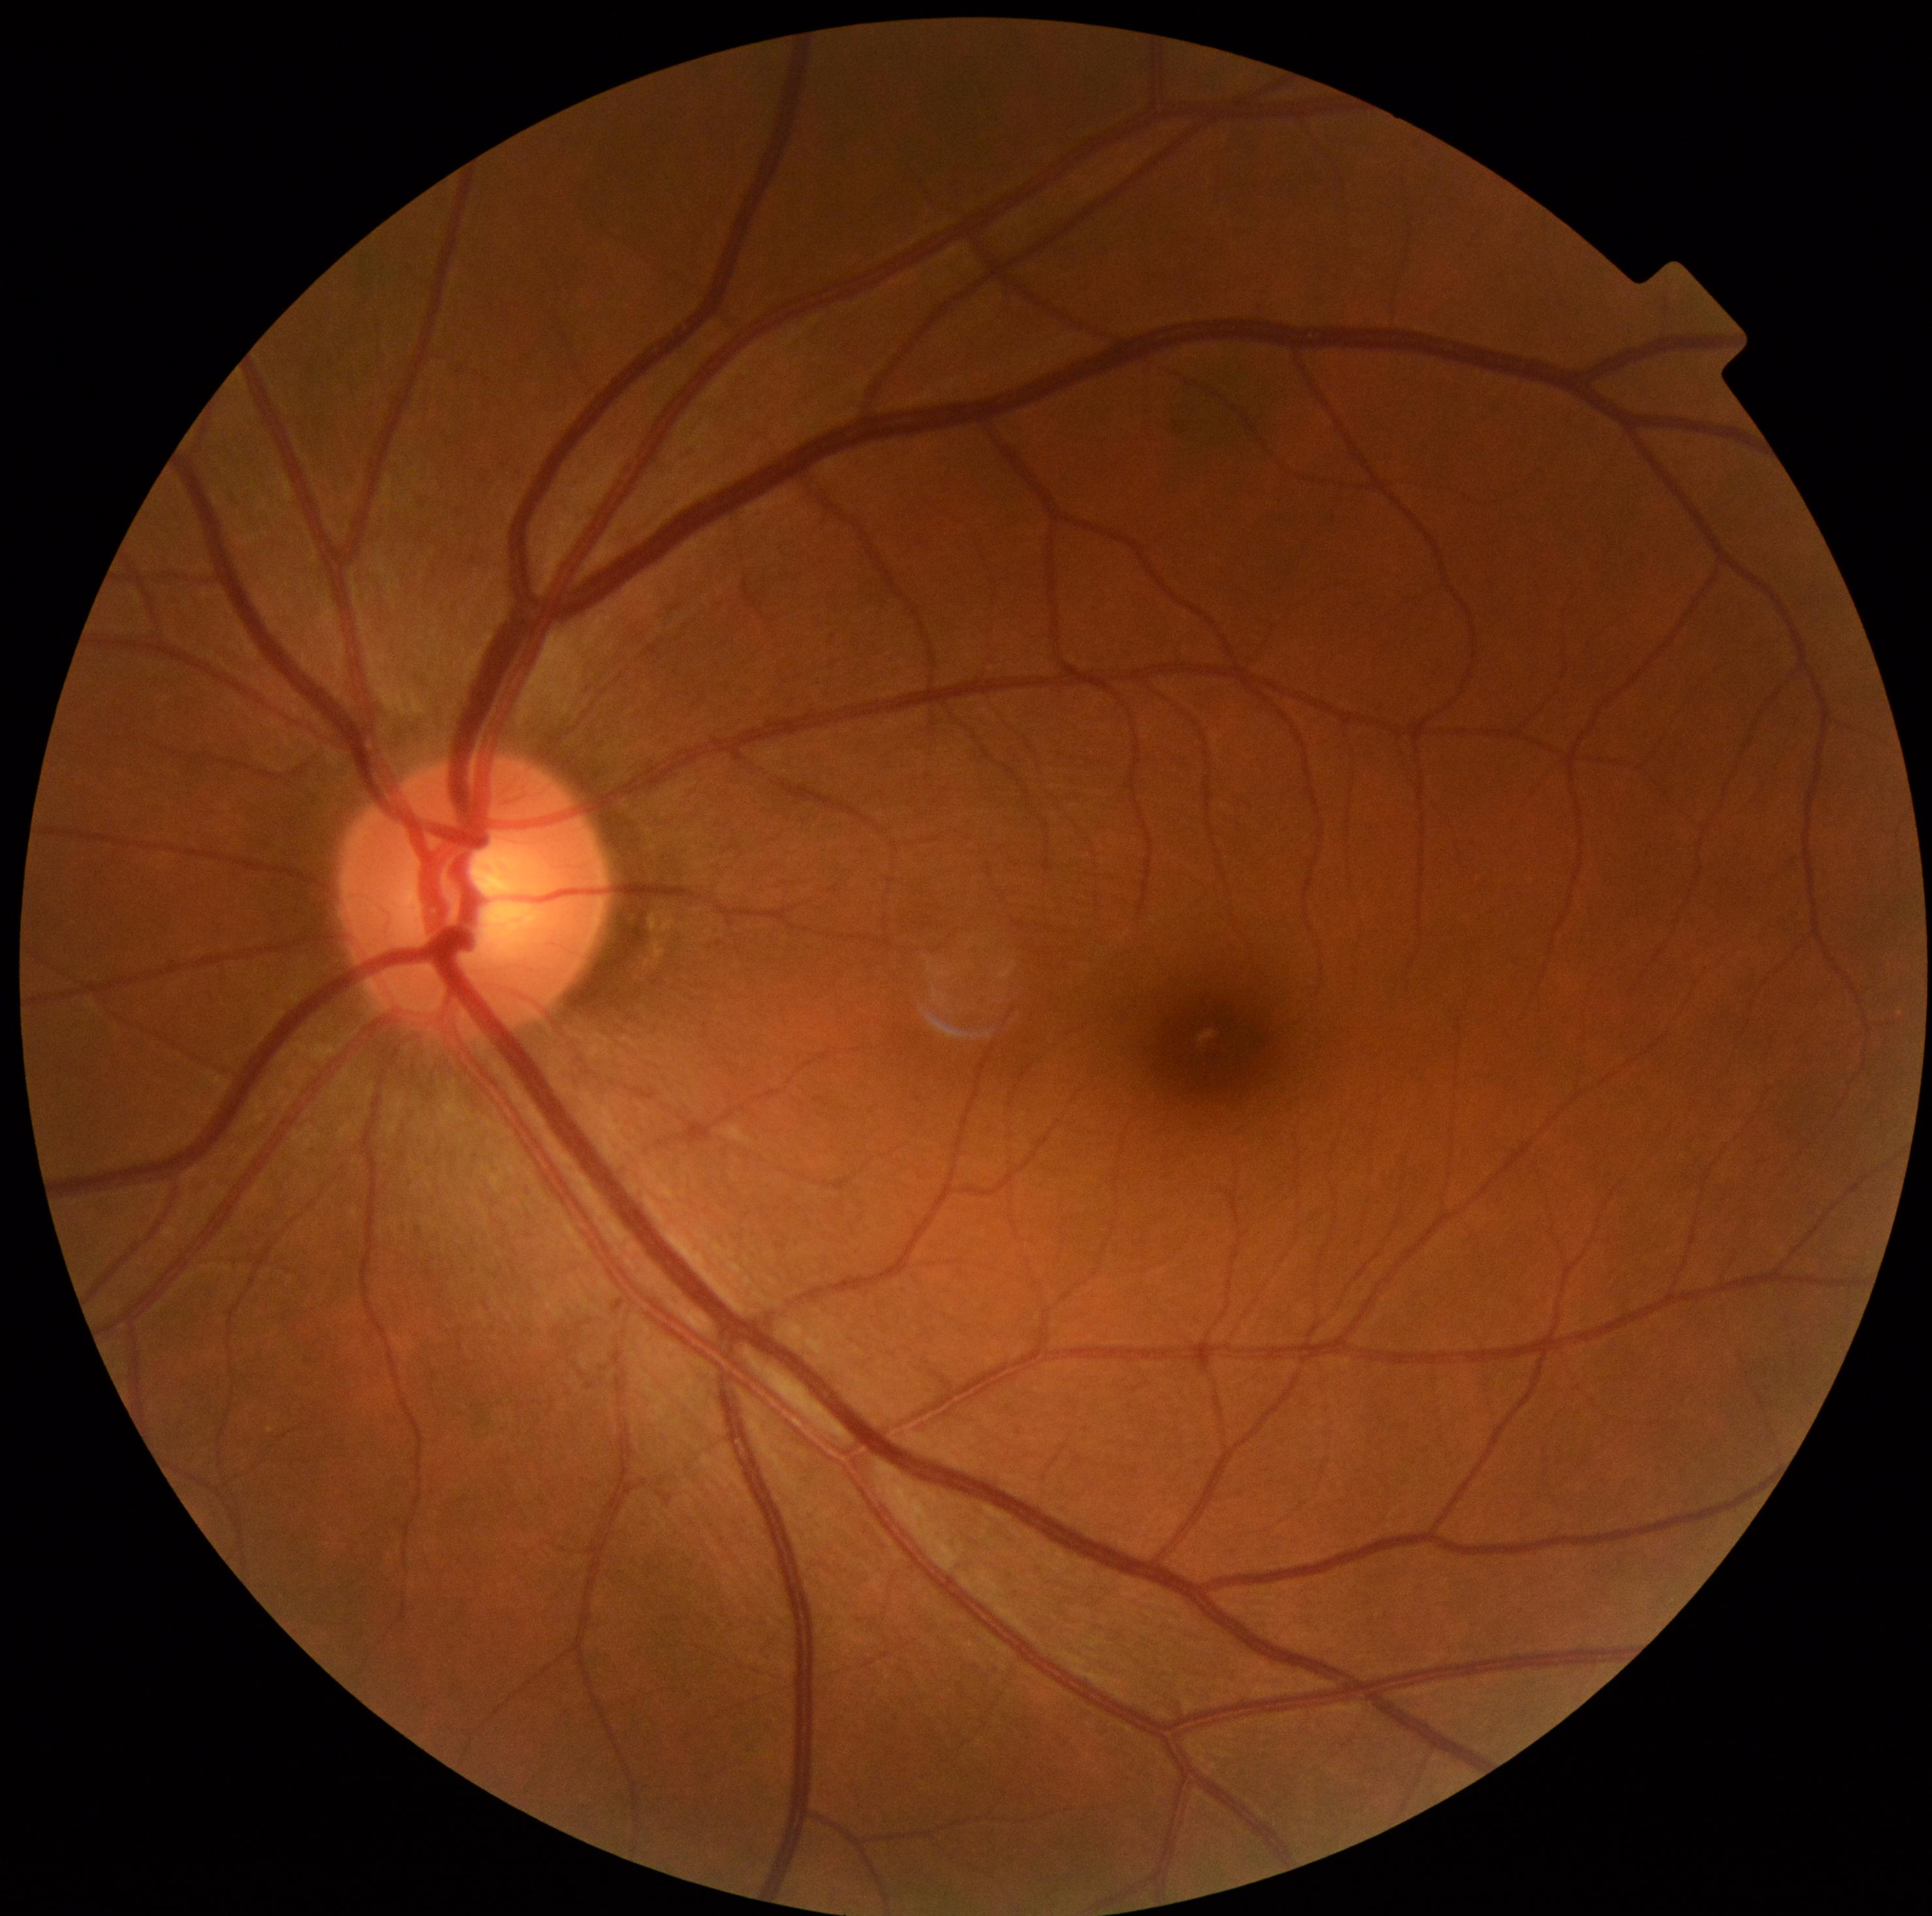 Diabetic retinopathy grade: 0.